FOV: 45 degrees · CFP — 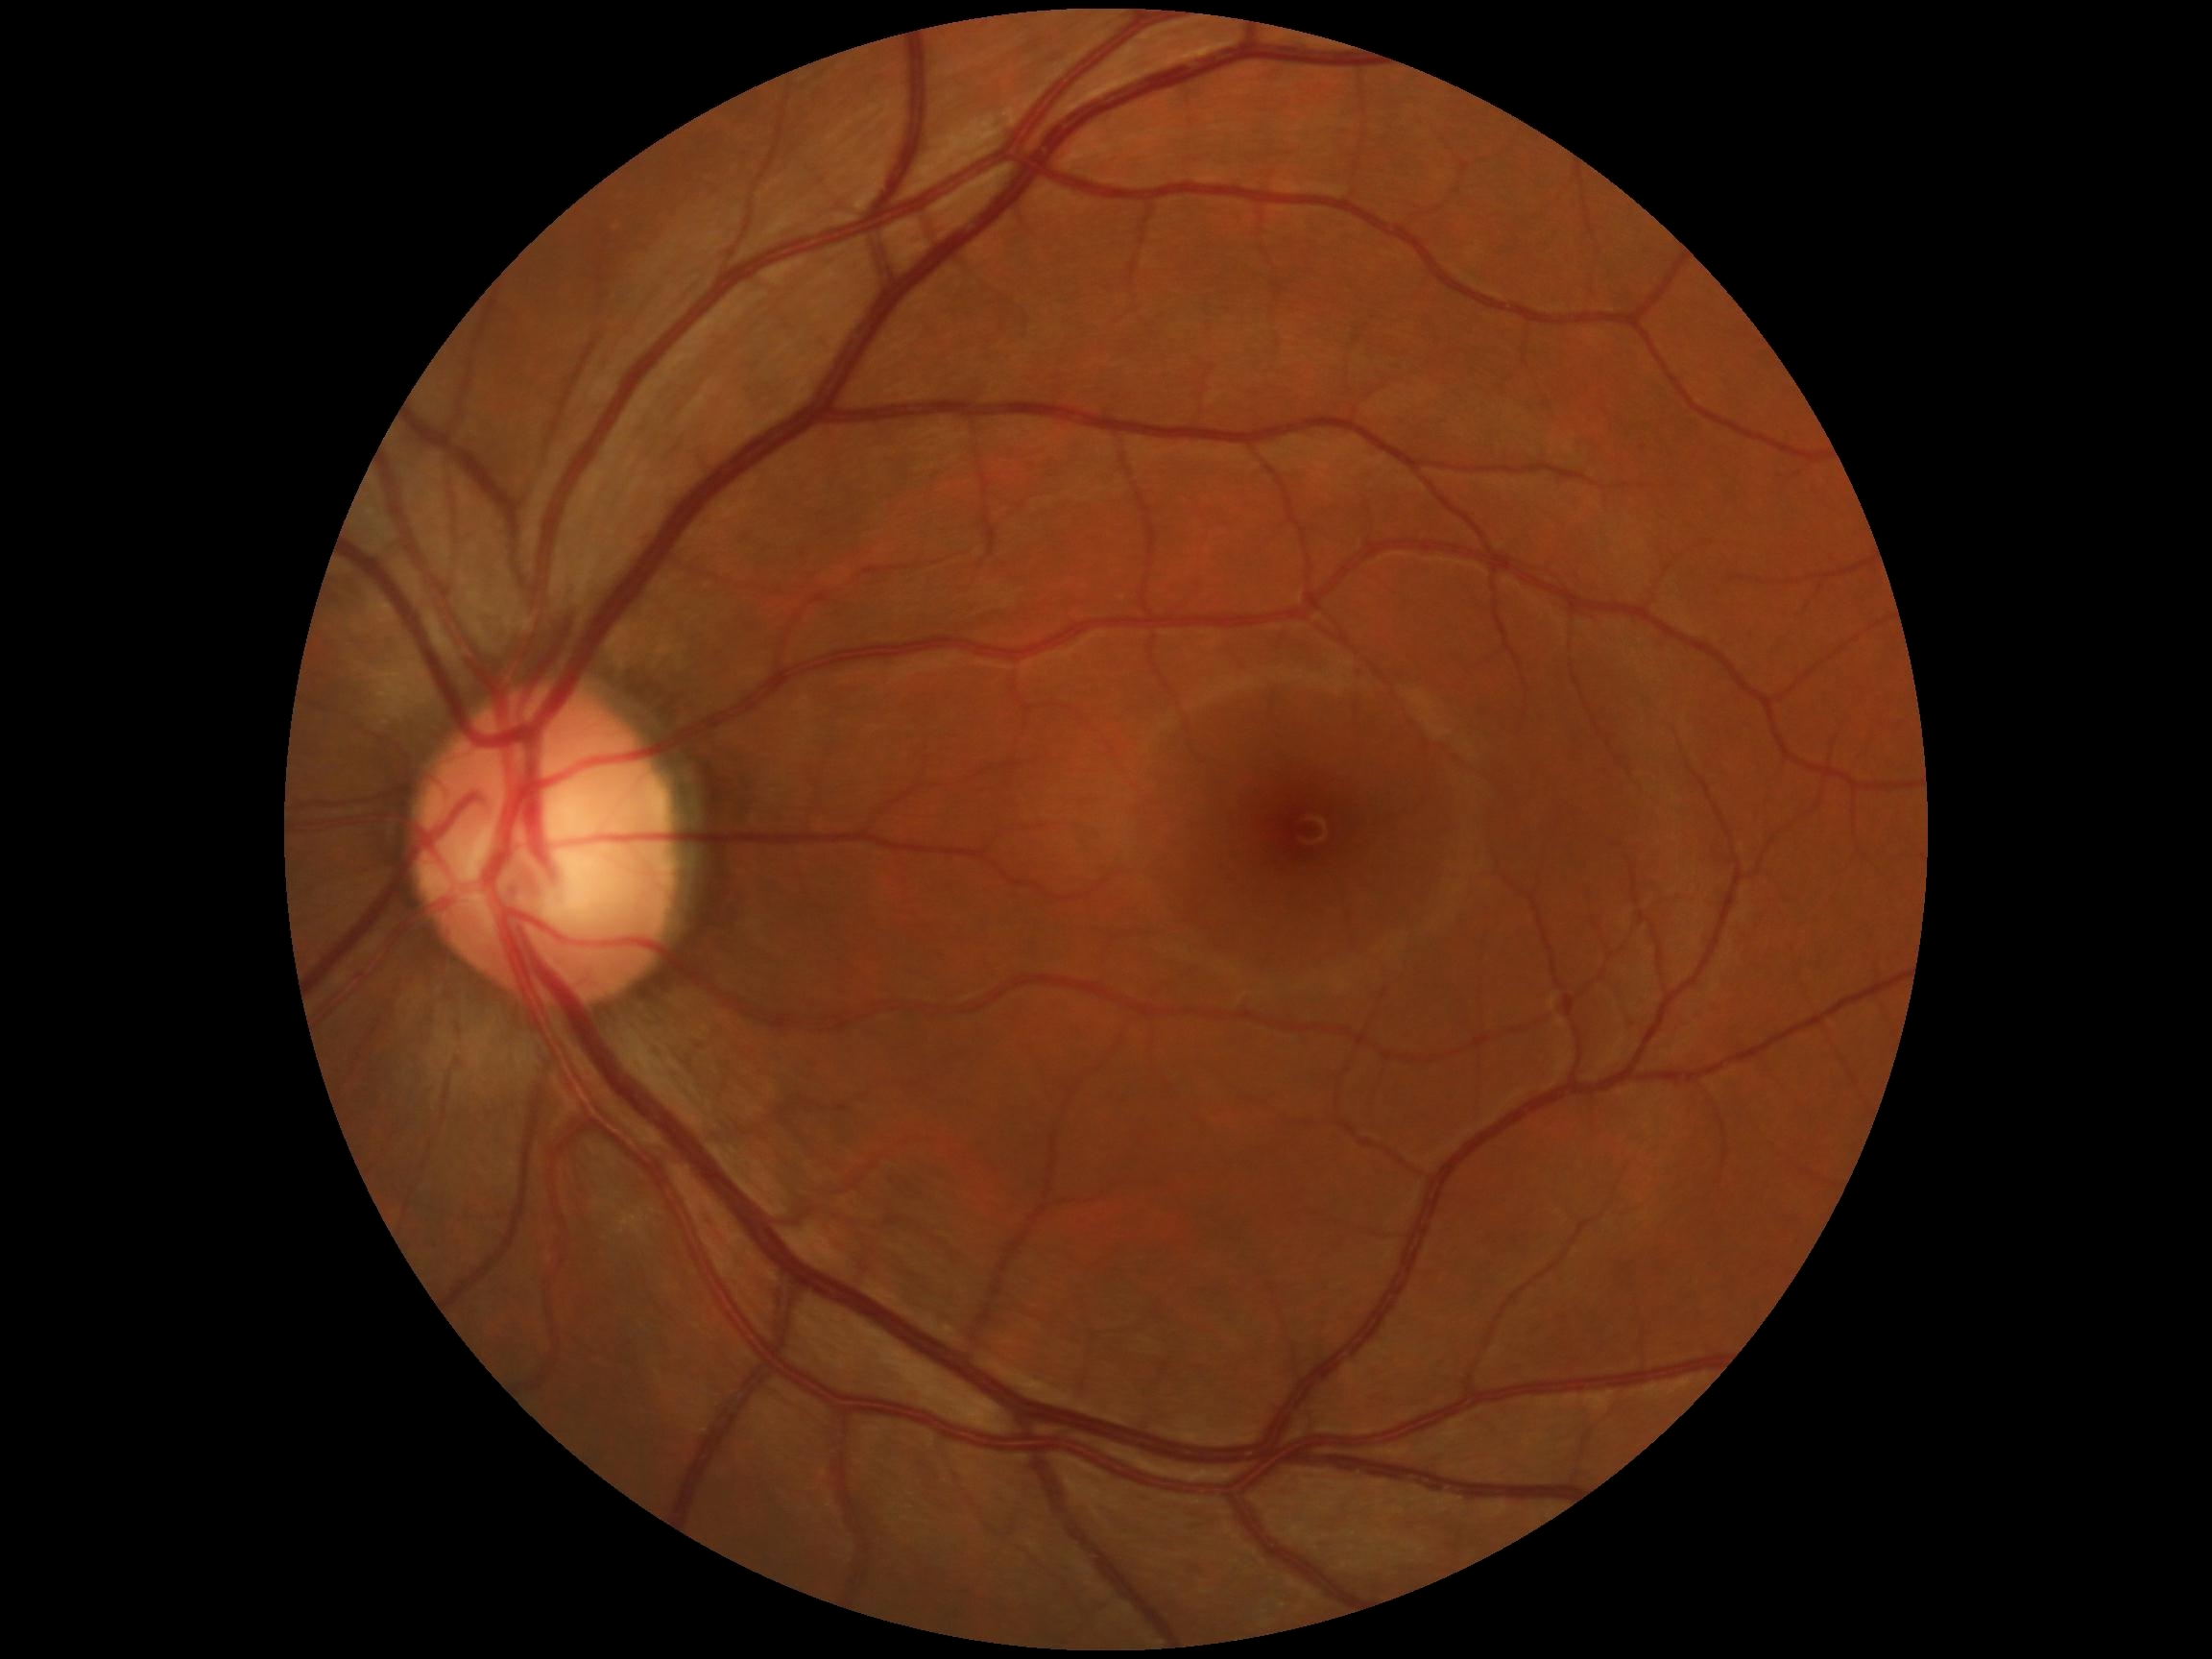 Diabetic retinopathy grade: 0.
No diabetic retinal disease findings.